45° FOV. Color fundus photograph.
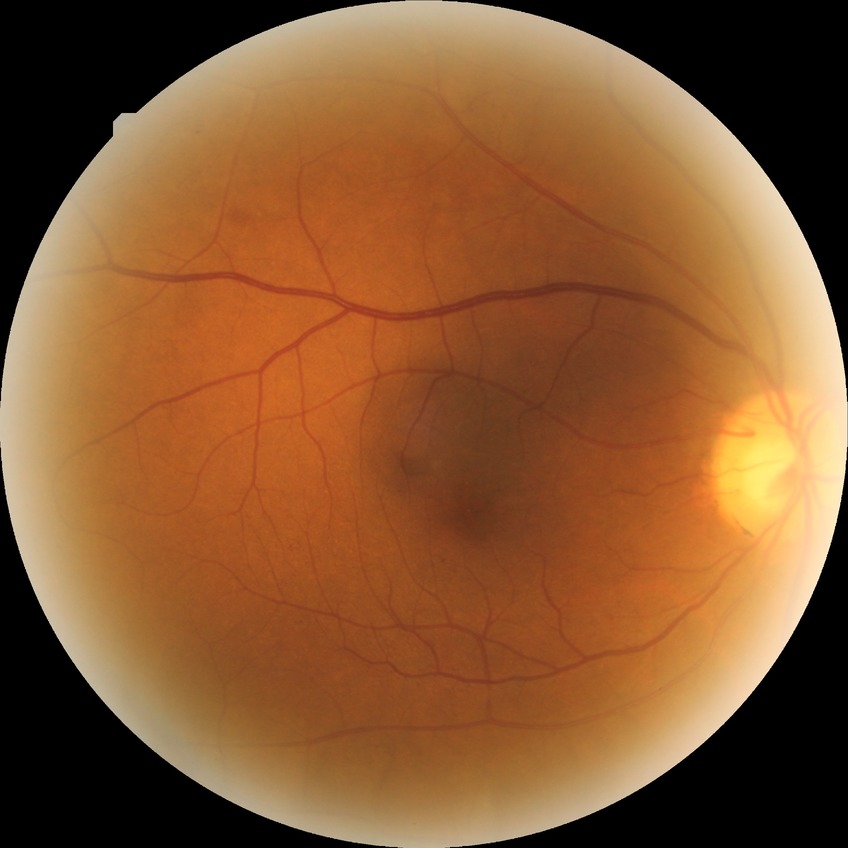

Diabetic retinopathy (DR) is pre-proliferative diabetic retinopathy (PPDR).